Fundus image cropped to the optic disc — 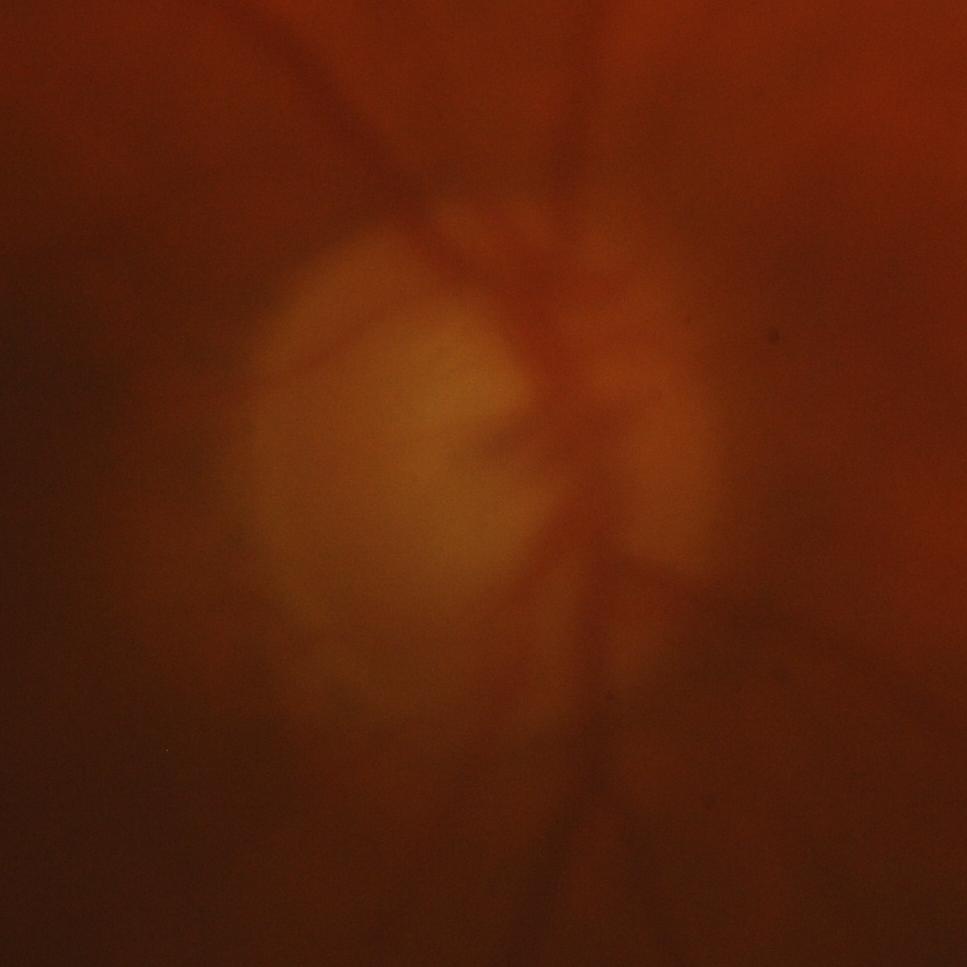
Q: Is there glaucomatous optic neuropathy?
A: Glaucomatous damage to the optic nerve.